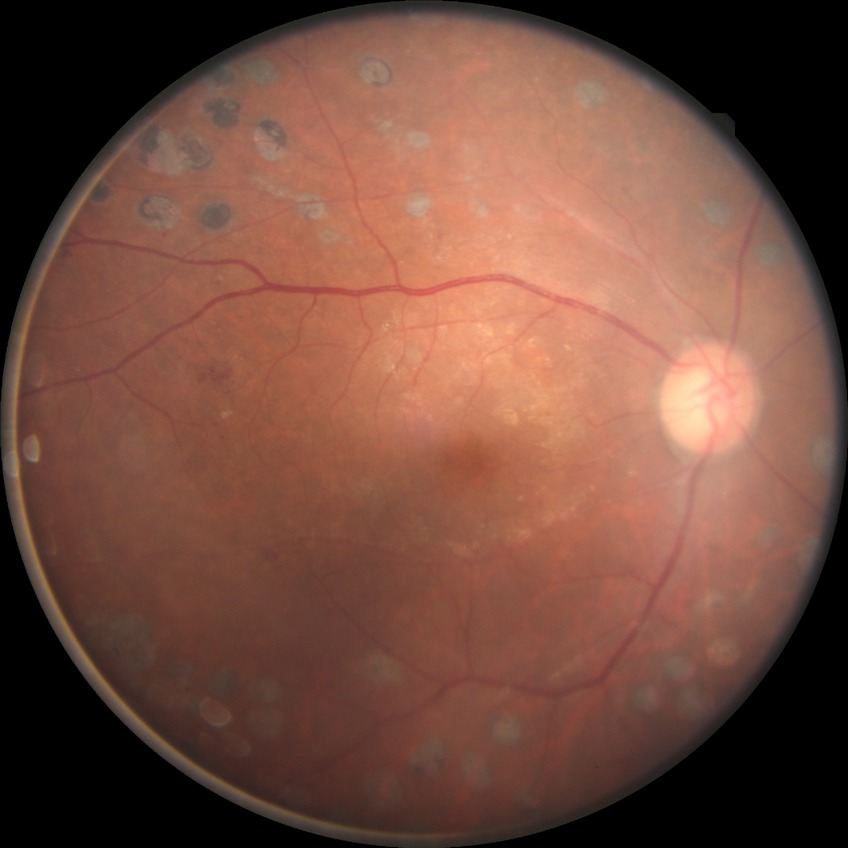
Diabetic retinopathy (DR): proliferative diabetic retinopathy (PDR).